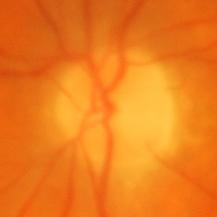 Glaucomatous optic neuropathy is present. Showing glaucomatous findings.